45° field of view. Fundus photo. 2352 by 1568 pixels
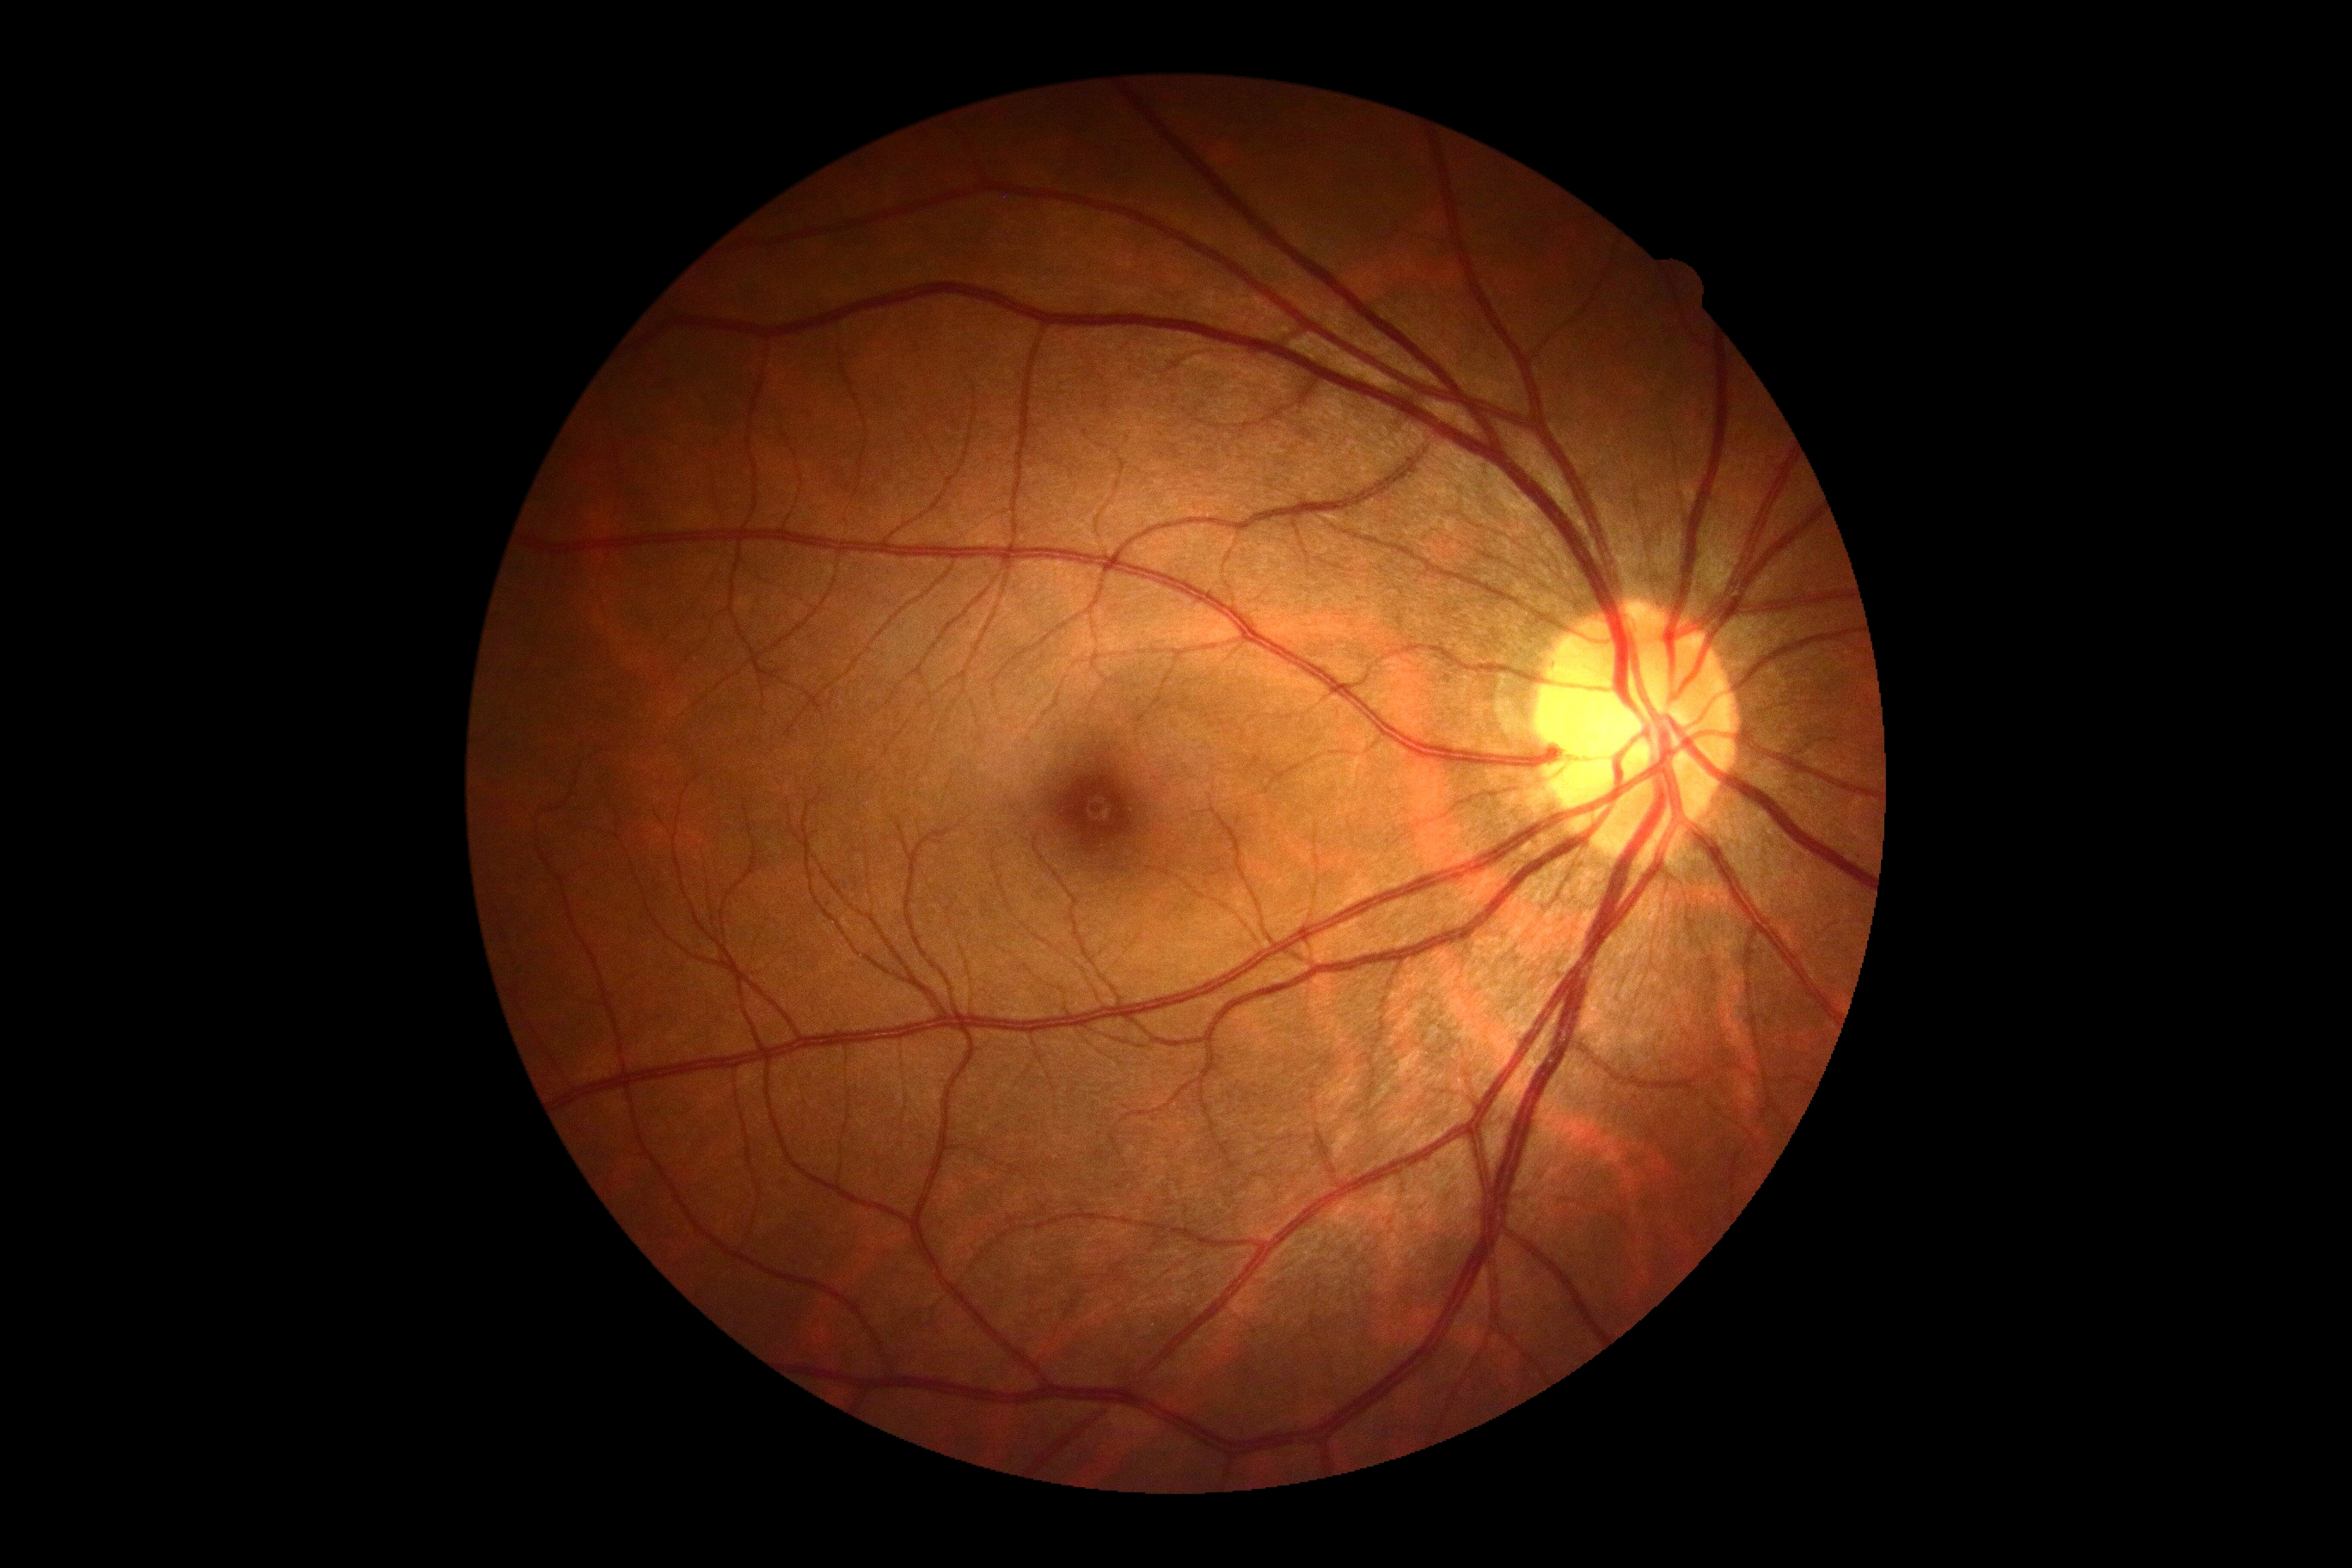 diabetic retinopathy (DR): grade 0.